Pediatric retinal photograph (wide-field). Captured with the Natus RetCam Envision (130° field of view)
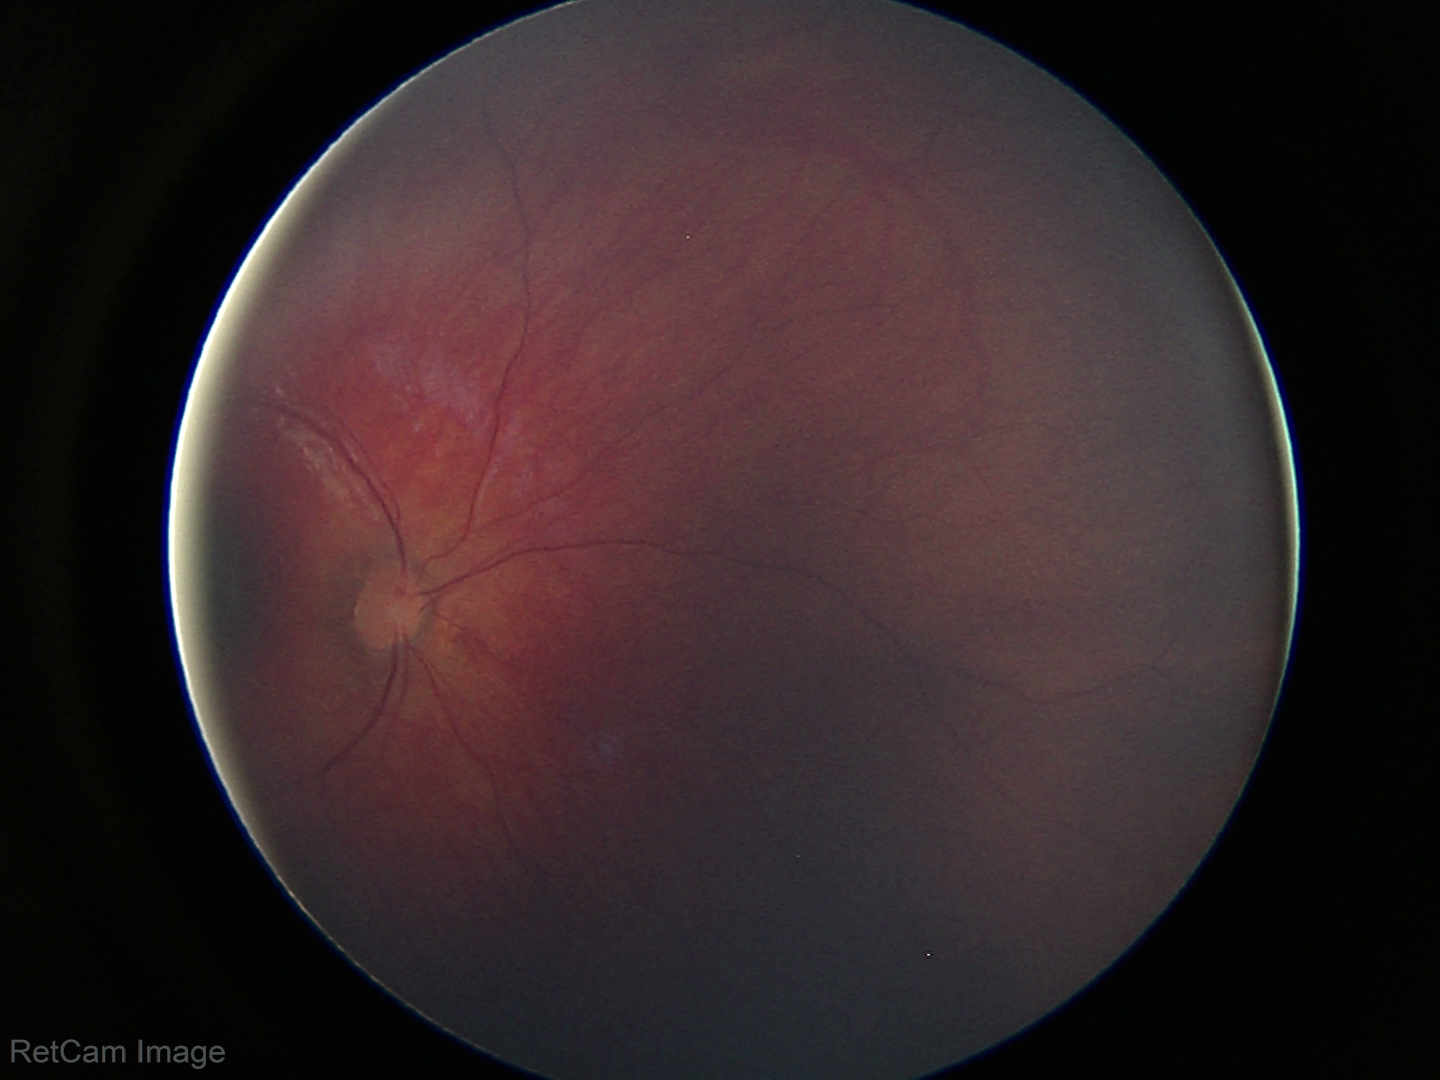 Normal screening examination.